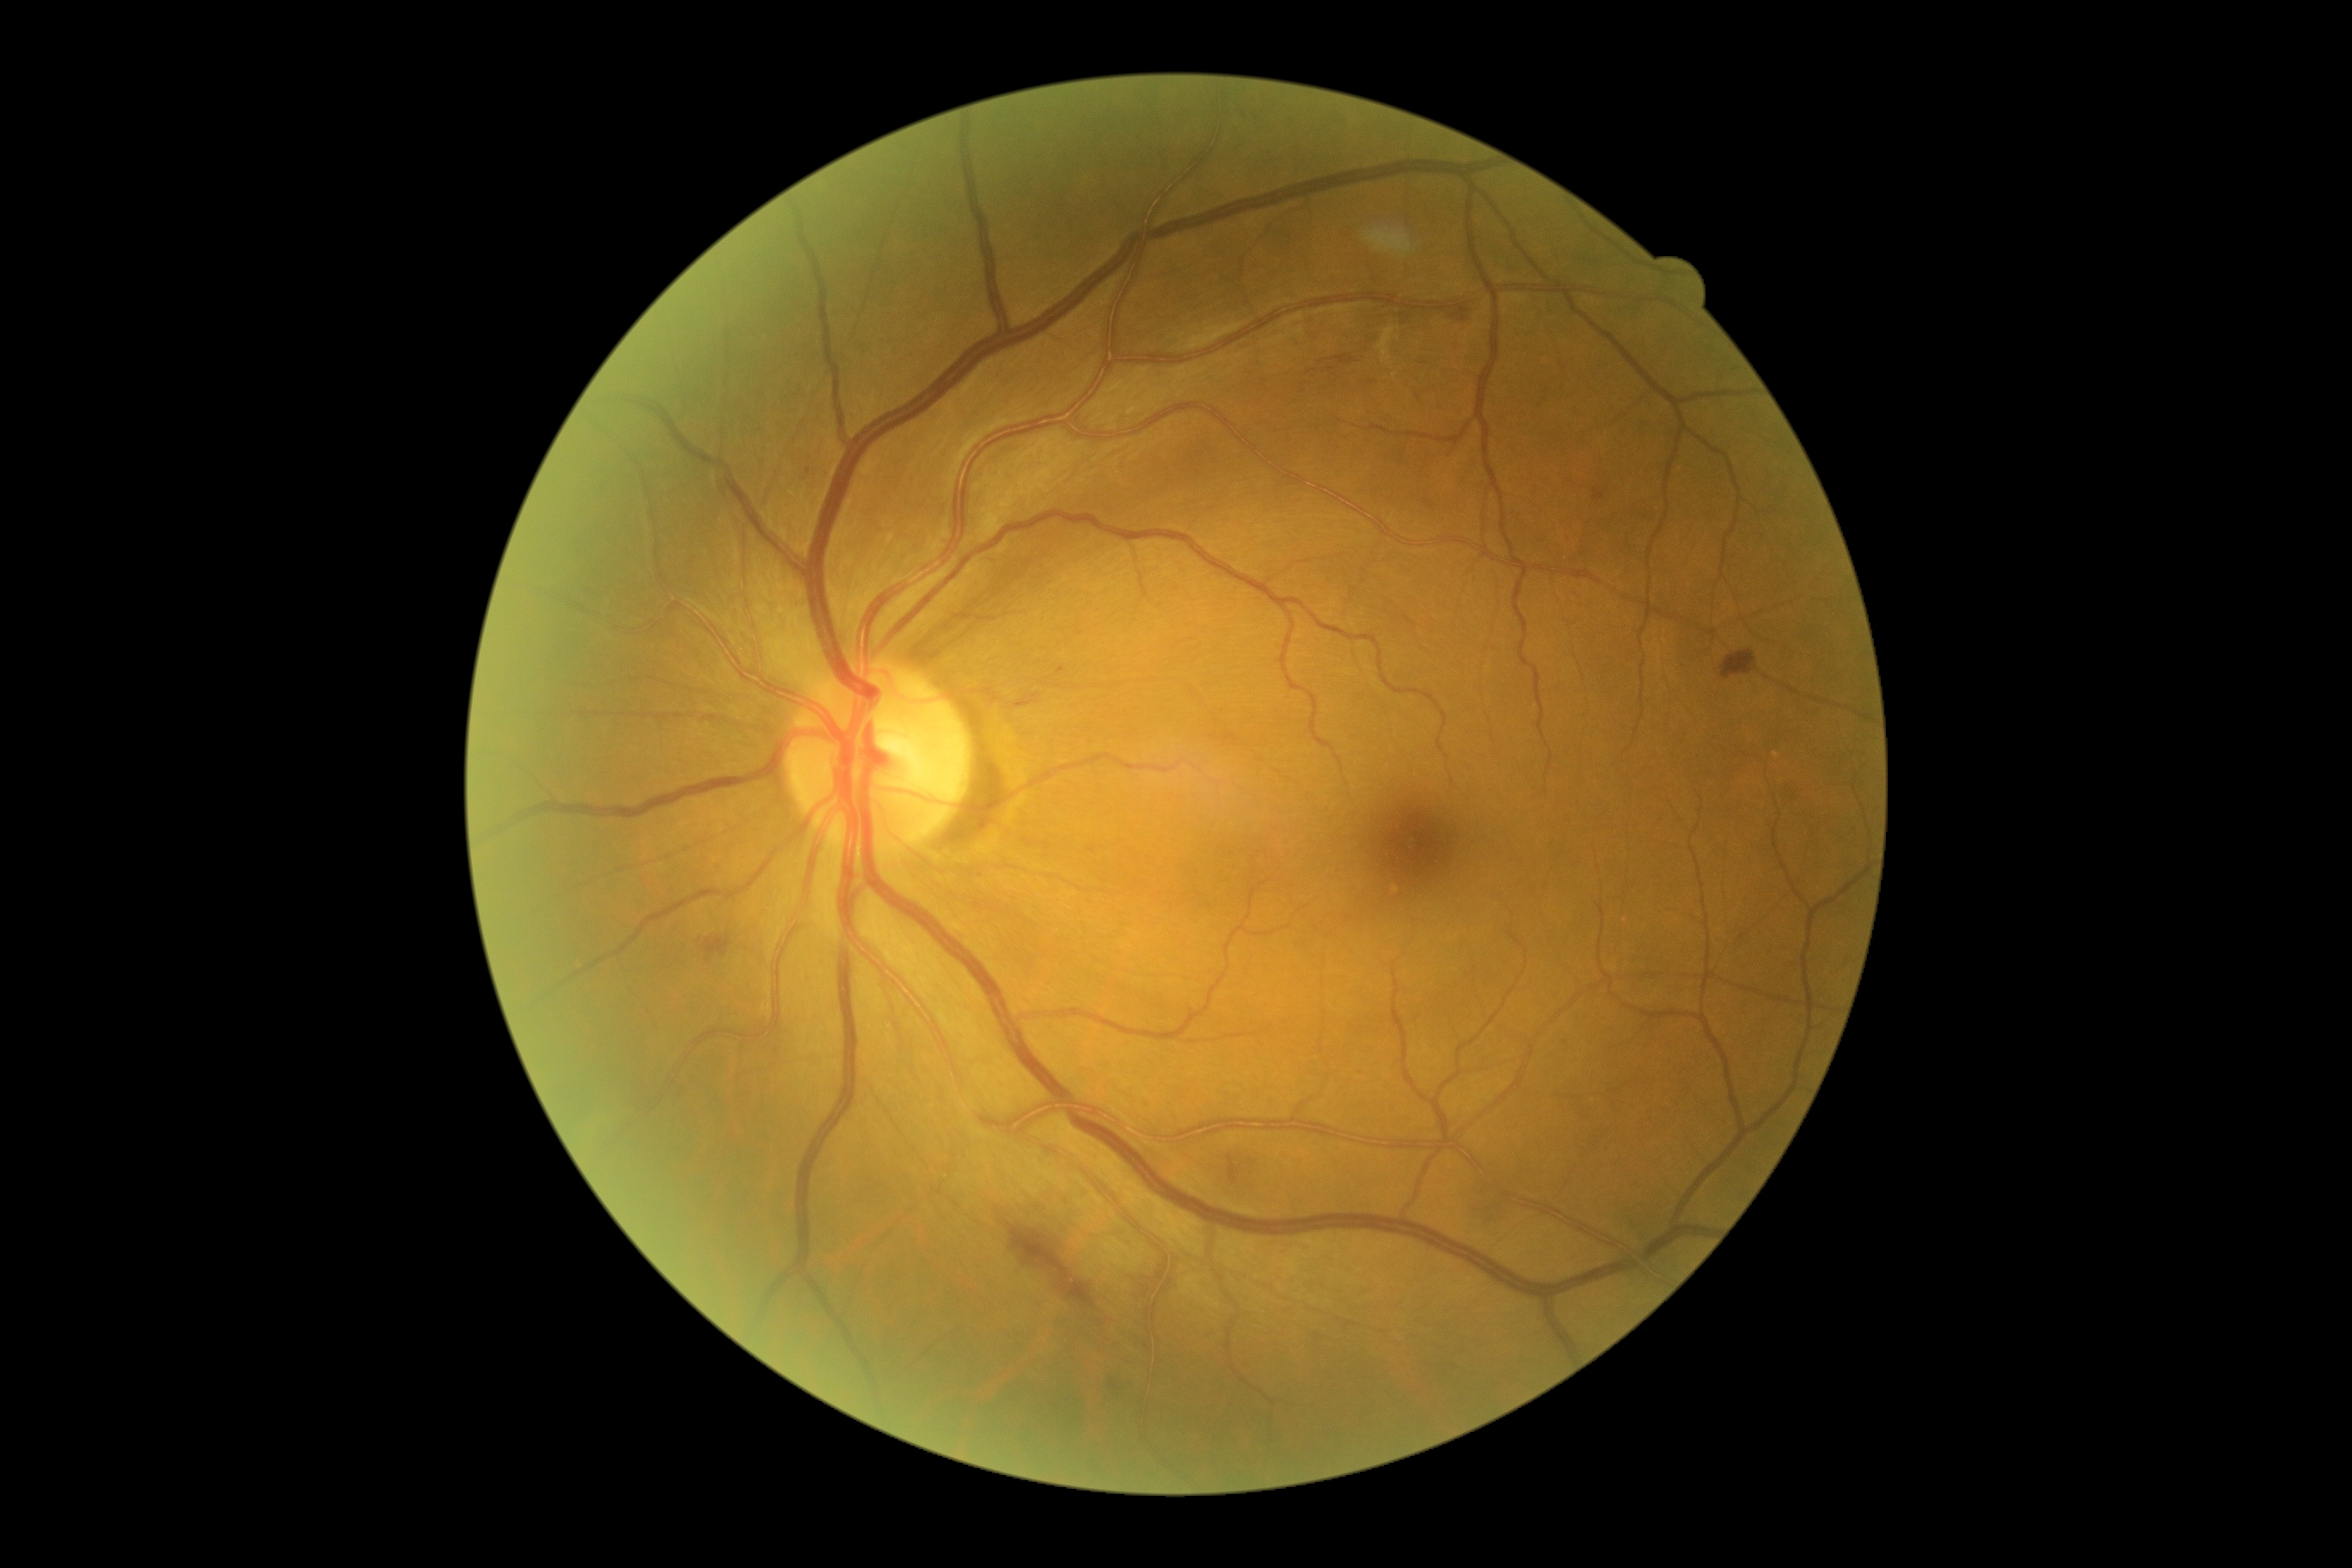
DR class=non-proliferative diabetic retinopathy; DR stage=moderate non-proliferative diabetic retinopathy (grade 2).